Posterior pole color fundus photograph, image size 848x848, nonmydriatic fundus photograph, modified Davis classification, 45-degree field of view:
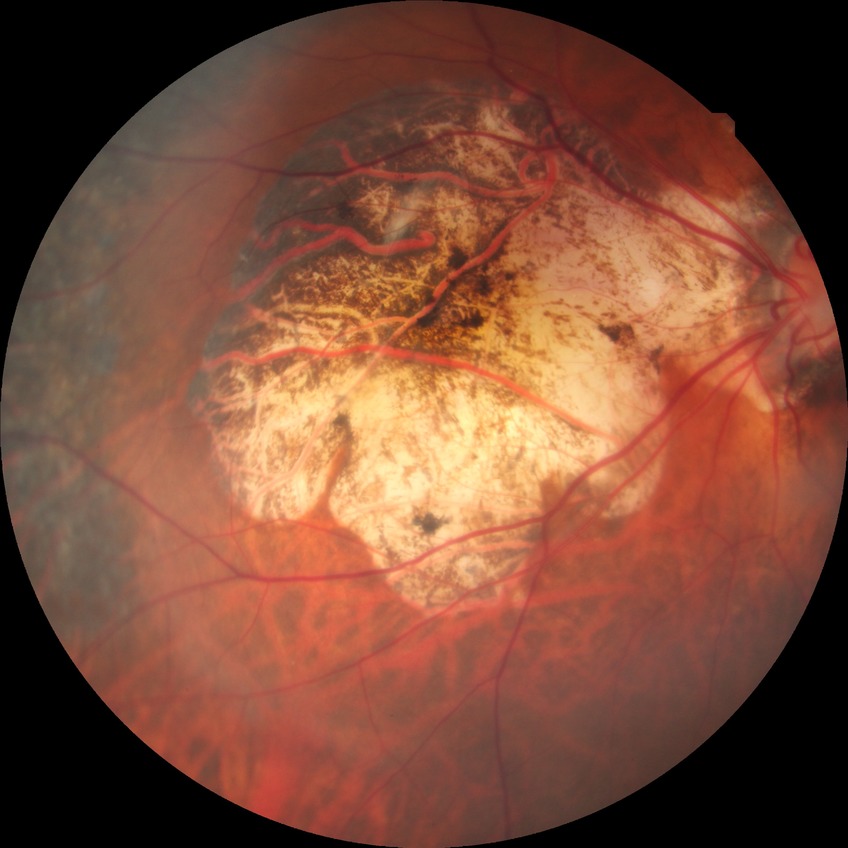

Diabetic retinopathy stage is simple diabetic retinopathy.